Acquired on the Phoenix ICON · infant wide-field fundus photograph:
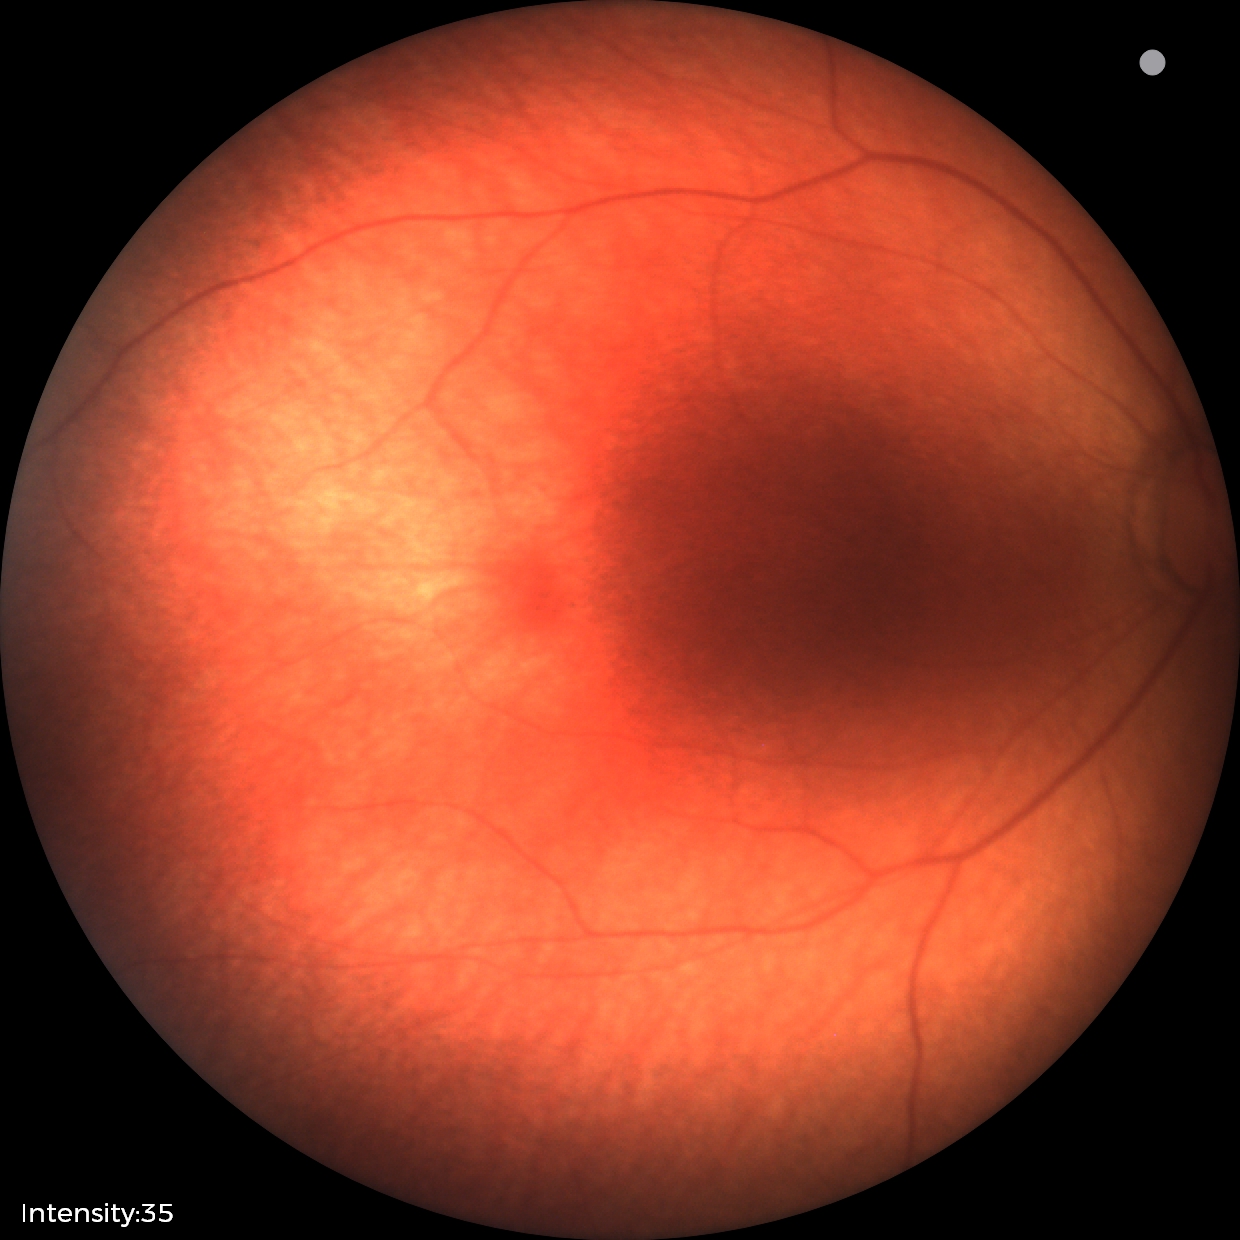

Screening diagnosis: no abnormalities.